Posterior pole photograph · NIDEK AFC-230 fundus camera:
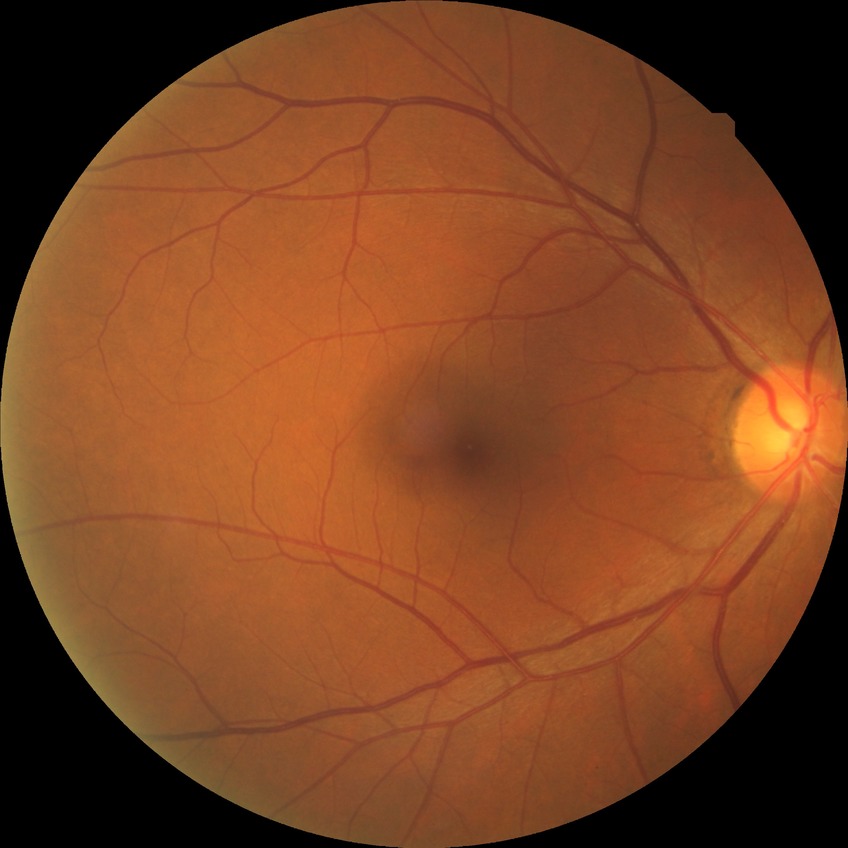
Diabetic retinopathy (DR): NDR (no diabetic retinopathy).